768x576, color fundus image:
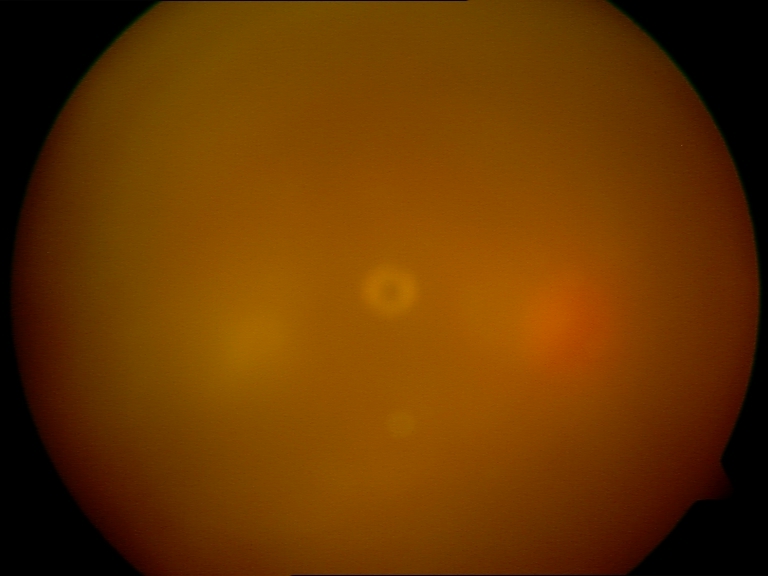

Gradability: blurred, more than half the field obscured. Proliferative retinopathy: not identified.